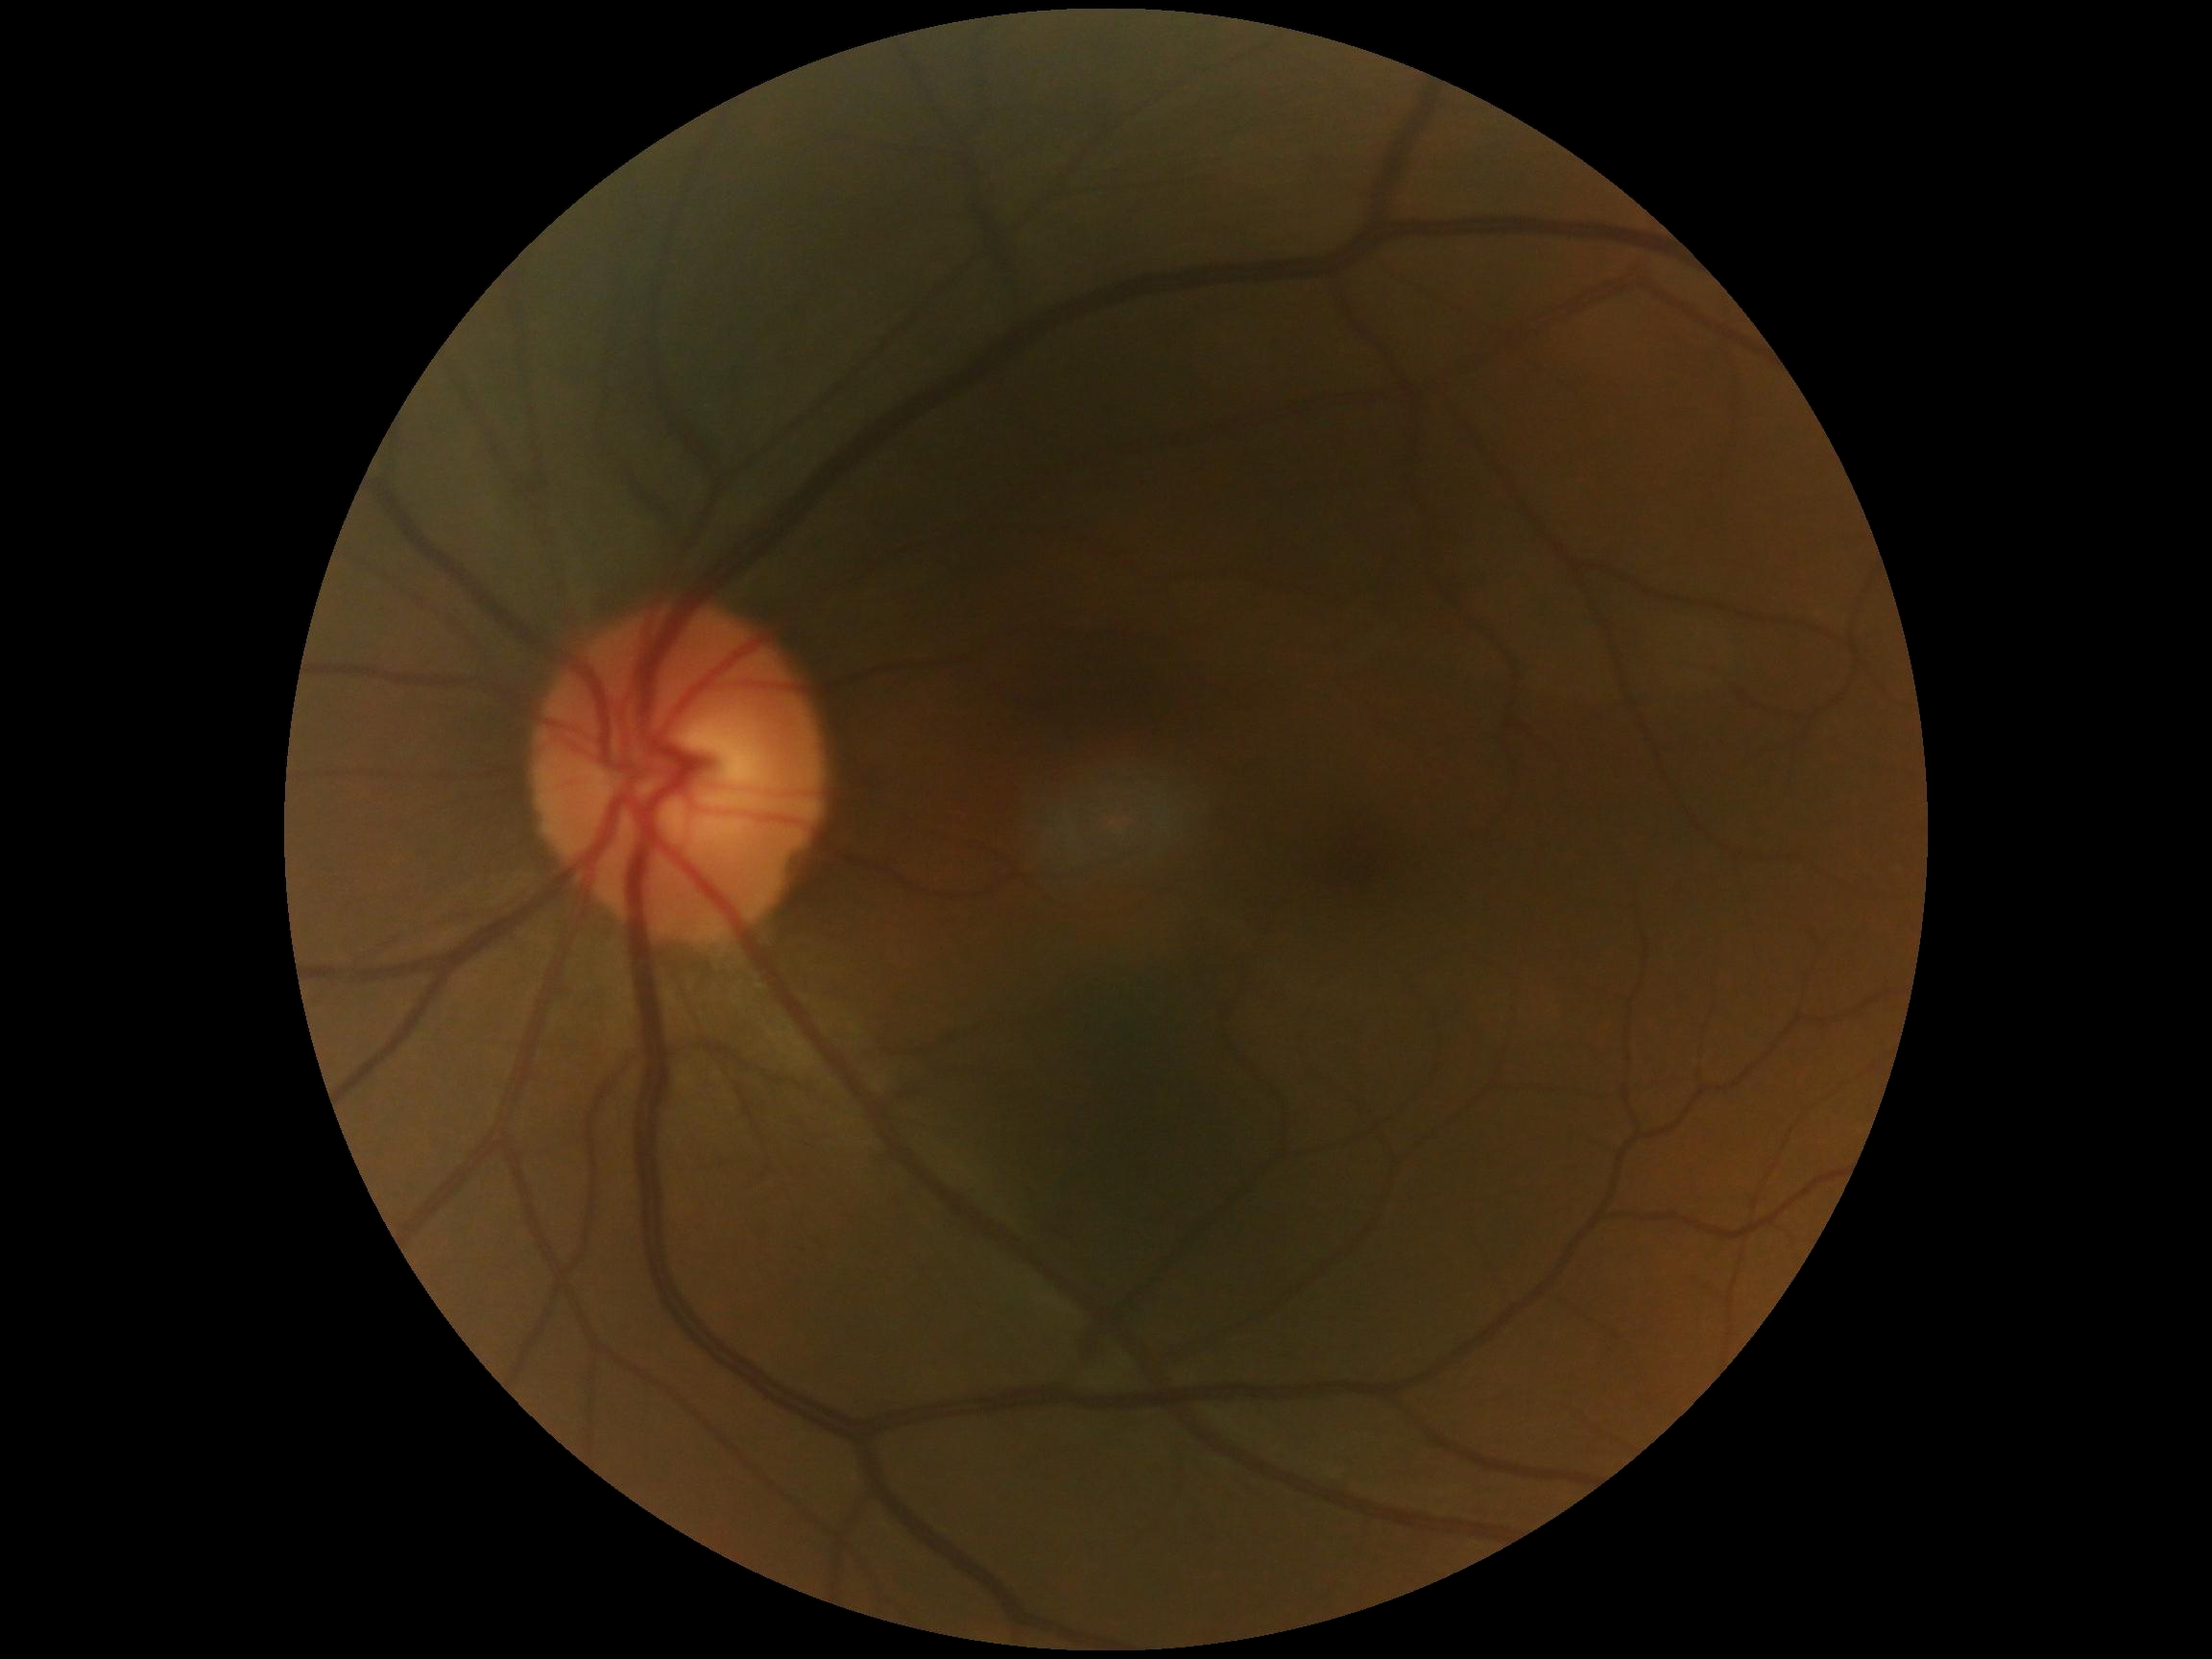
diabetic retinopathy severity = 0.